45° field of view. 2361 x 1568 pixels. Color fundus photograph
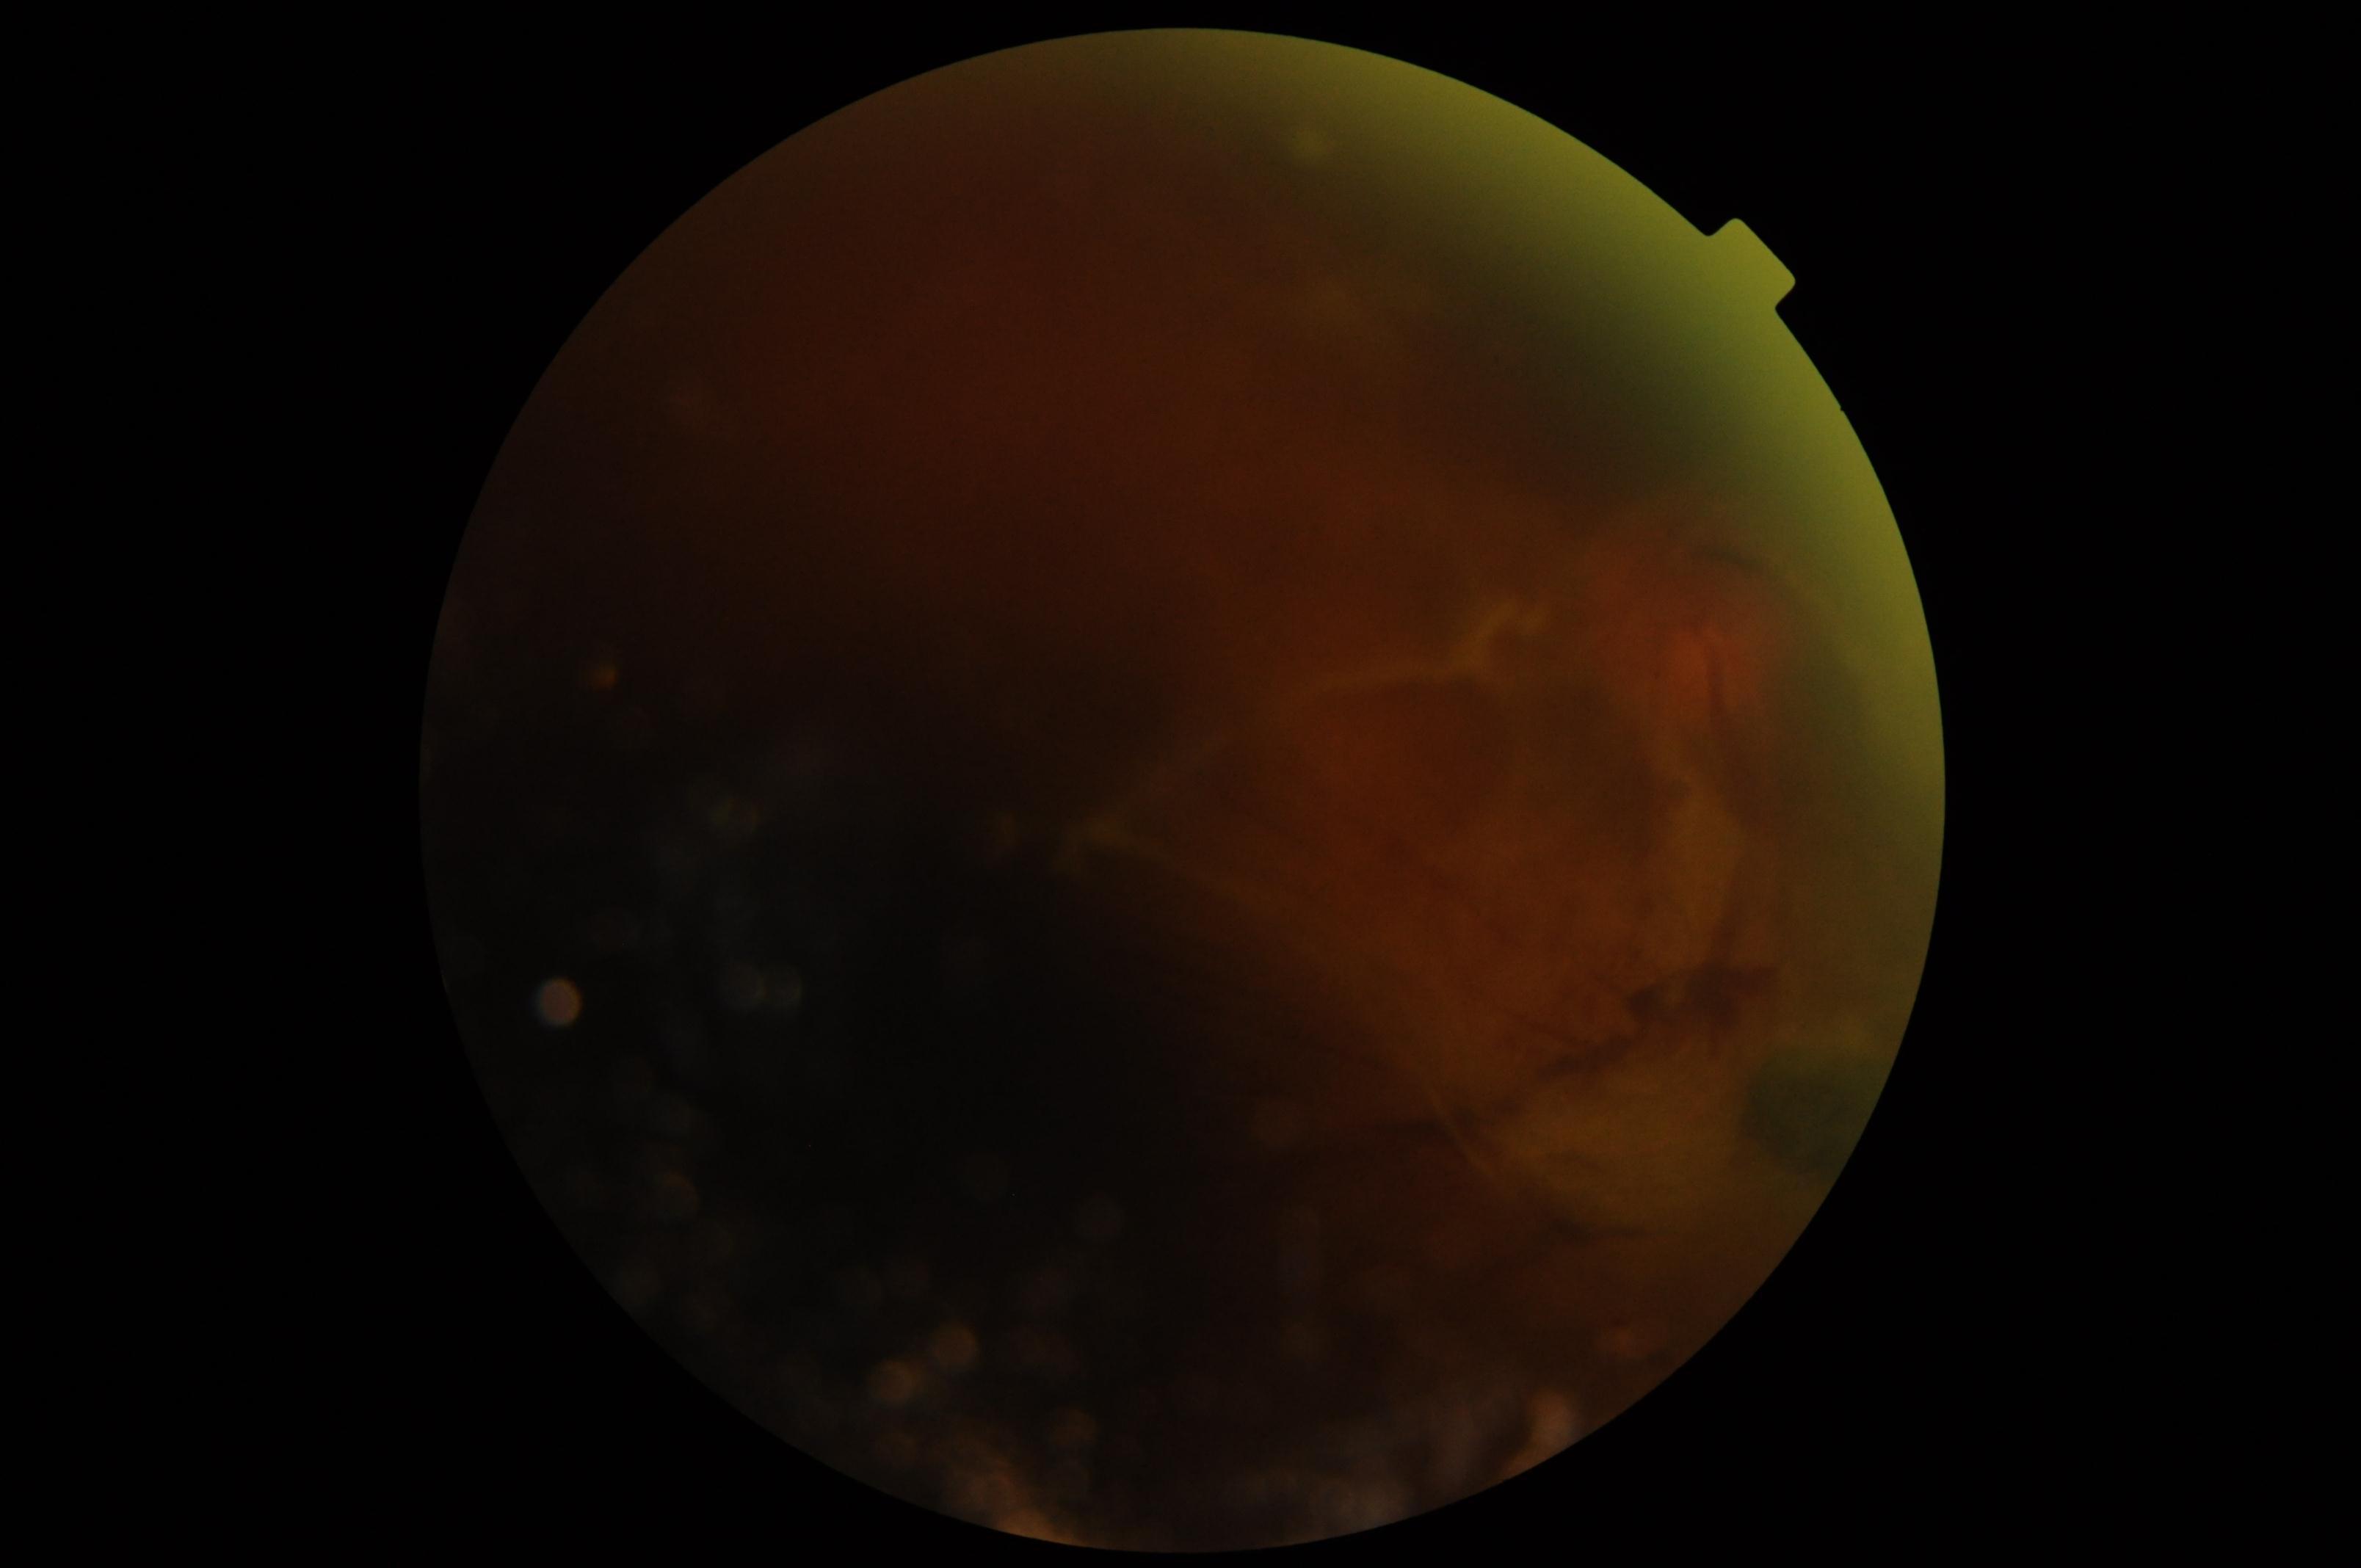
DR class: proliferative diabetic retinopathy.
Retinopathy: 4/4.